848 by 848 pixels. Posterior pole photograph:
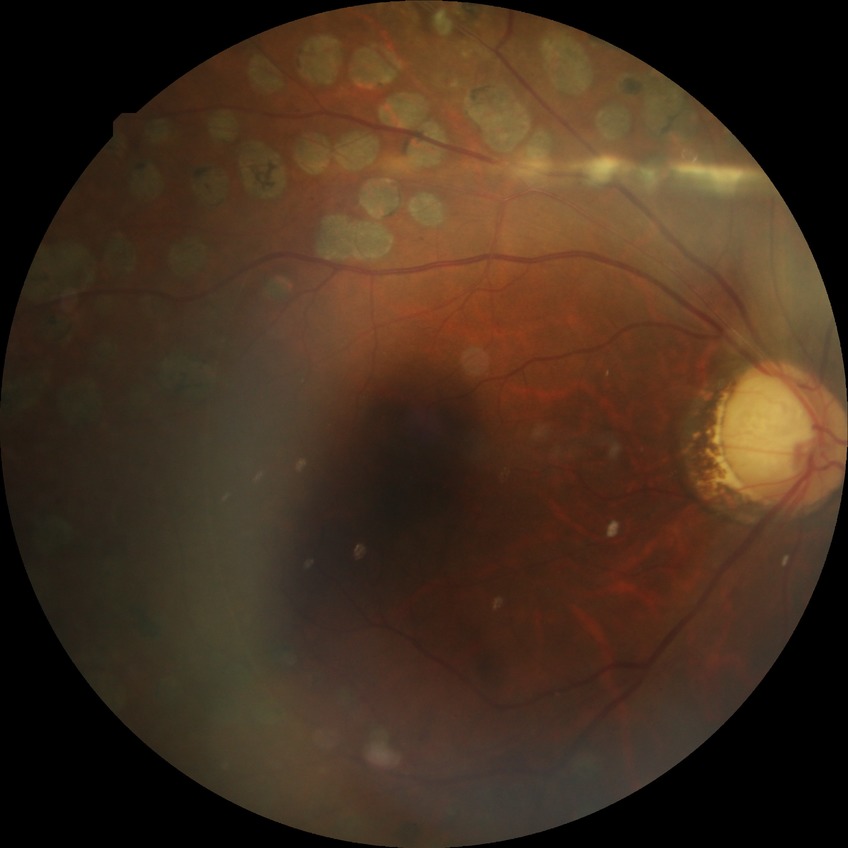
DR: PDR.